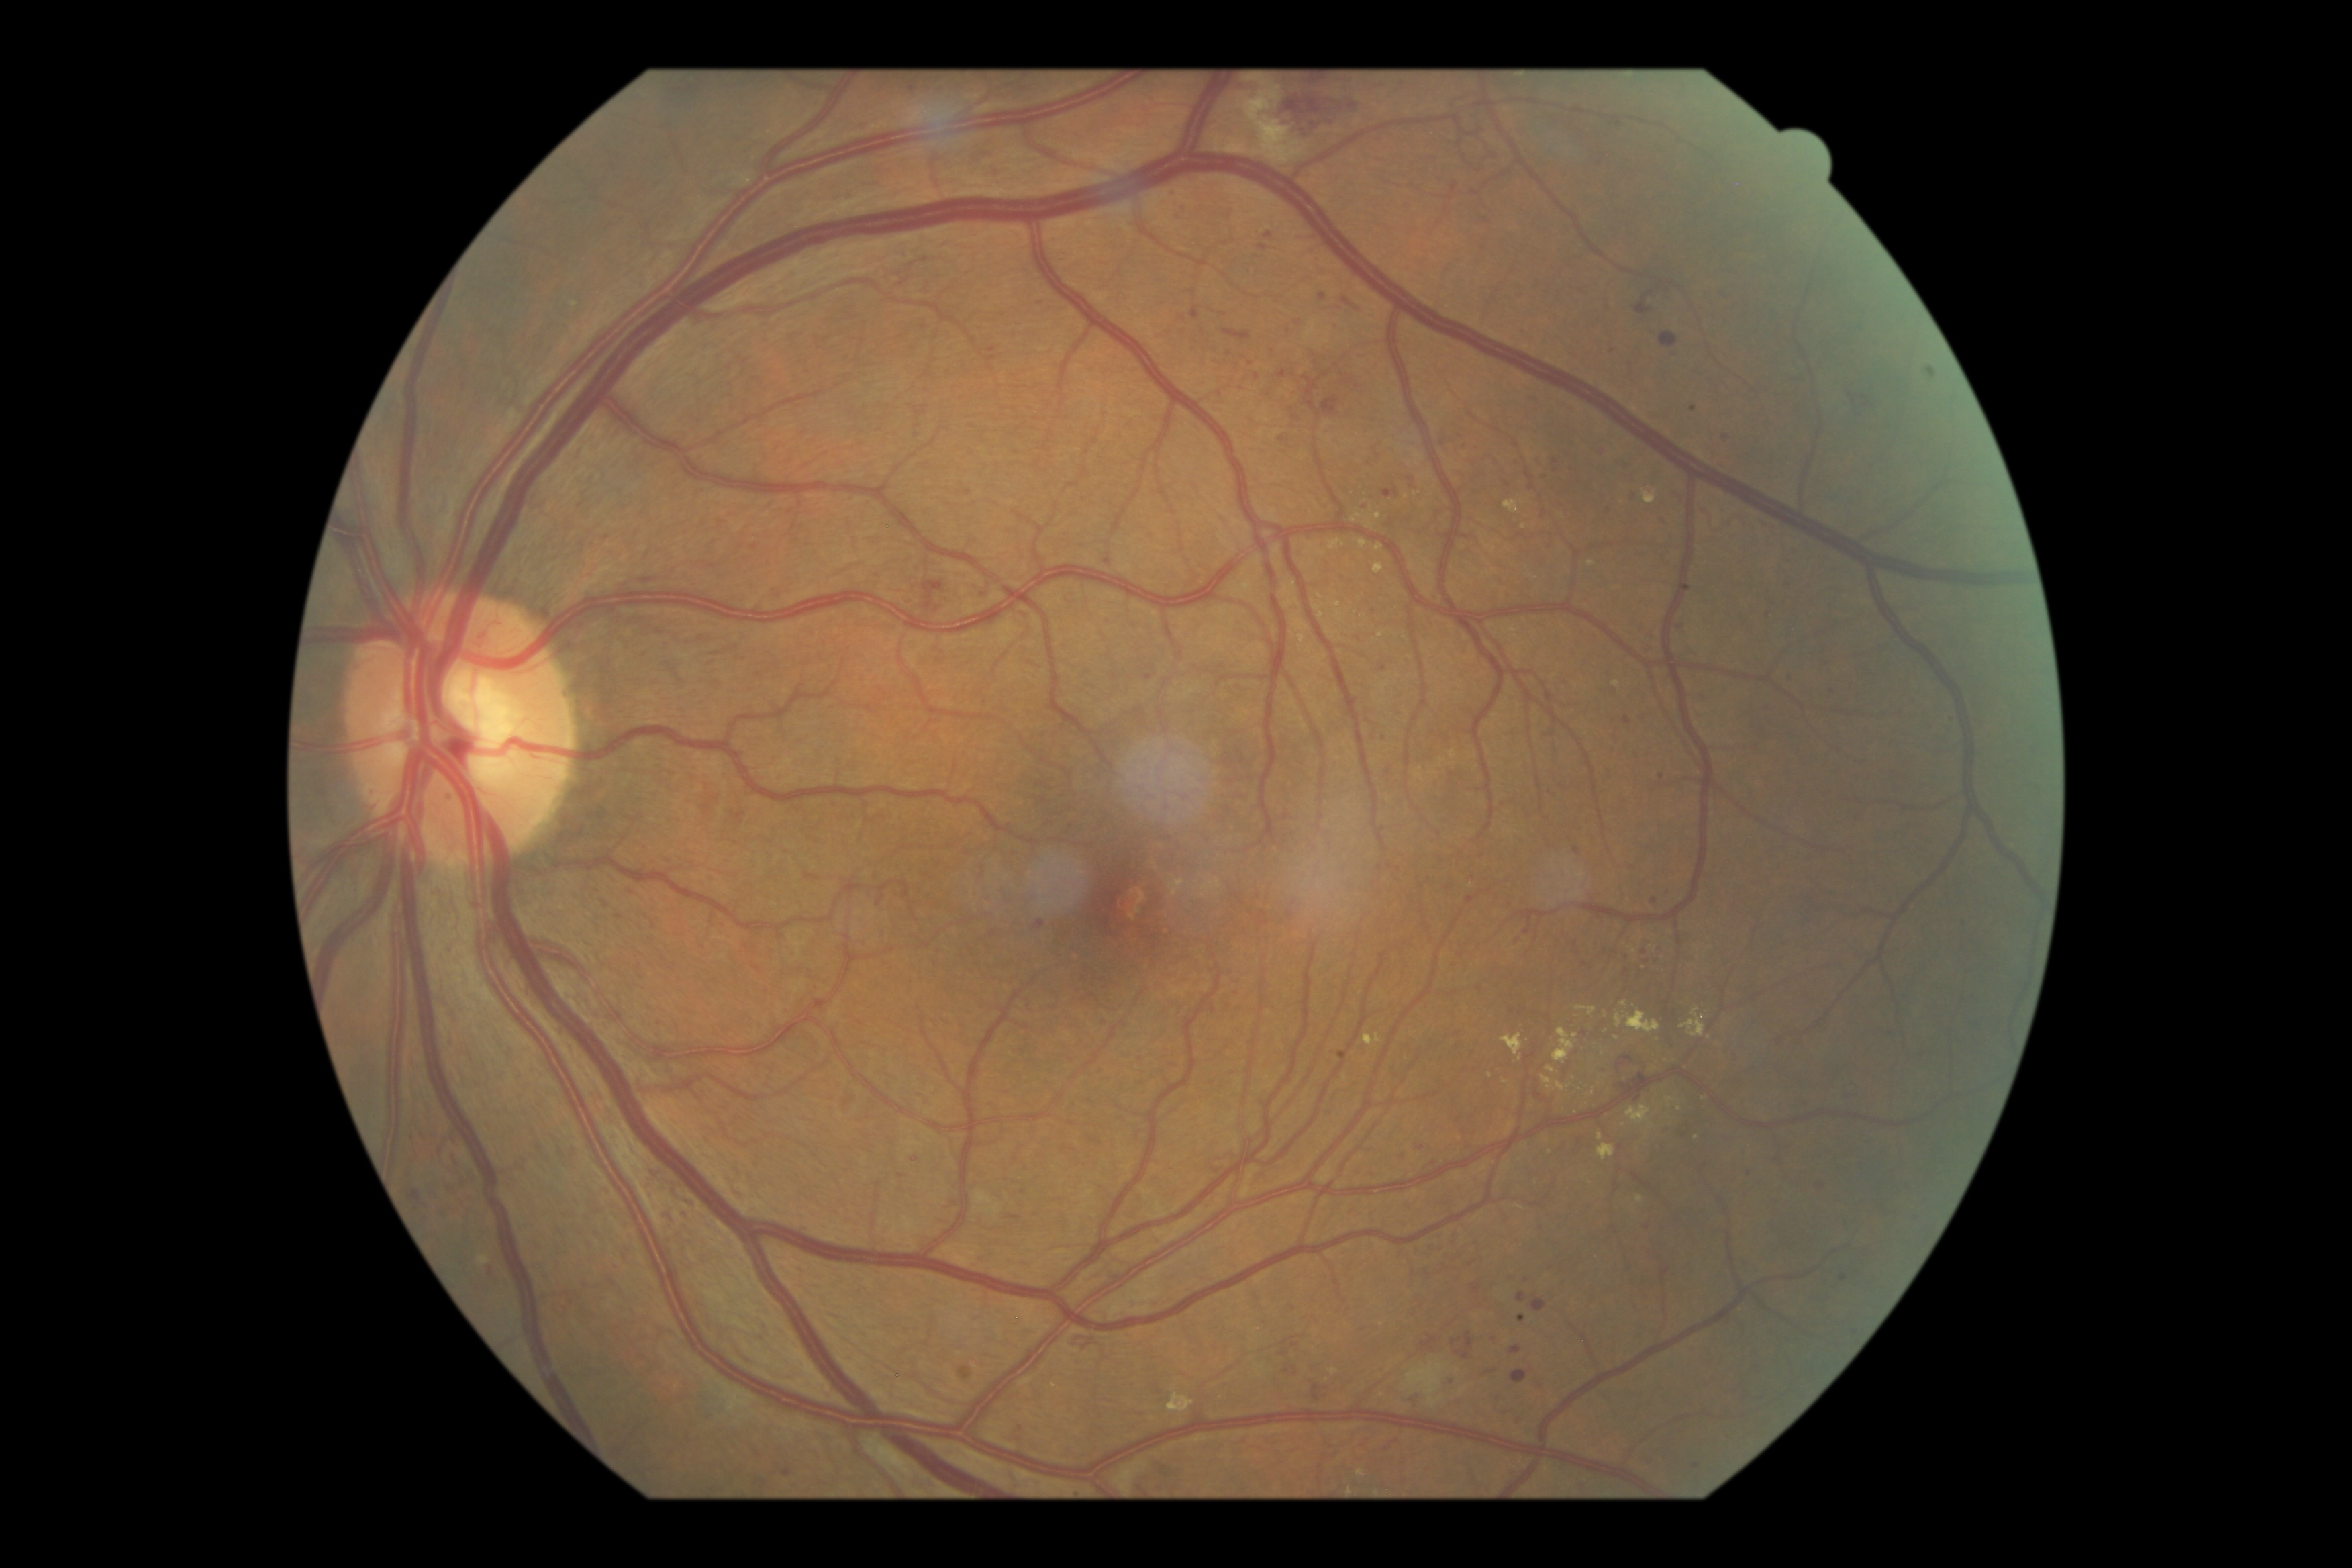
Diabetic retinopathy (DR): 3.
Microaneurysms (MAs) include BBox(1534, 457, 1542, 465) | BBox(1138, 1056, 1143, 1064) | BBox(1475, 1285, 1483, 1292) | BBox(1612, 347, 1617, 355) | BBox(783, 1469, 791, 1479) | BBox(1099, 1065, 1104, 1075) | BBox(1633, 491, 1640, 500).
MAs (small, approximate centers) near [1385, 736] | [1609, 509] | [1403, 1156] | [1635, 1306] | [1791, 678] | [1149, 678] | [1641, 950] | [1455, 964] | [1857, 1334] | [1389, 774] | [1337, 326].